Captured with the Phoenix ICON (100° field of view). Wide-field fundus photograph of an infant.
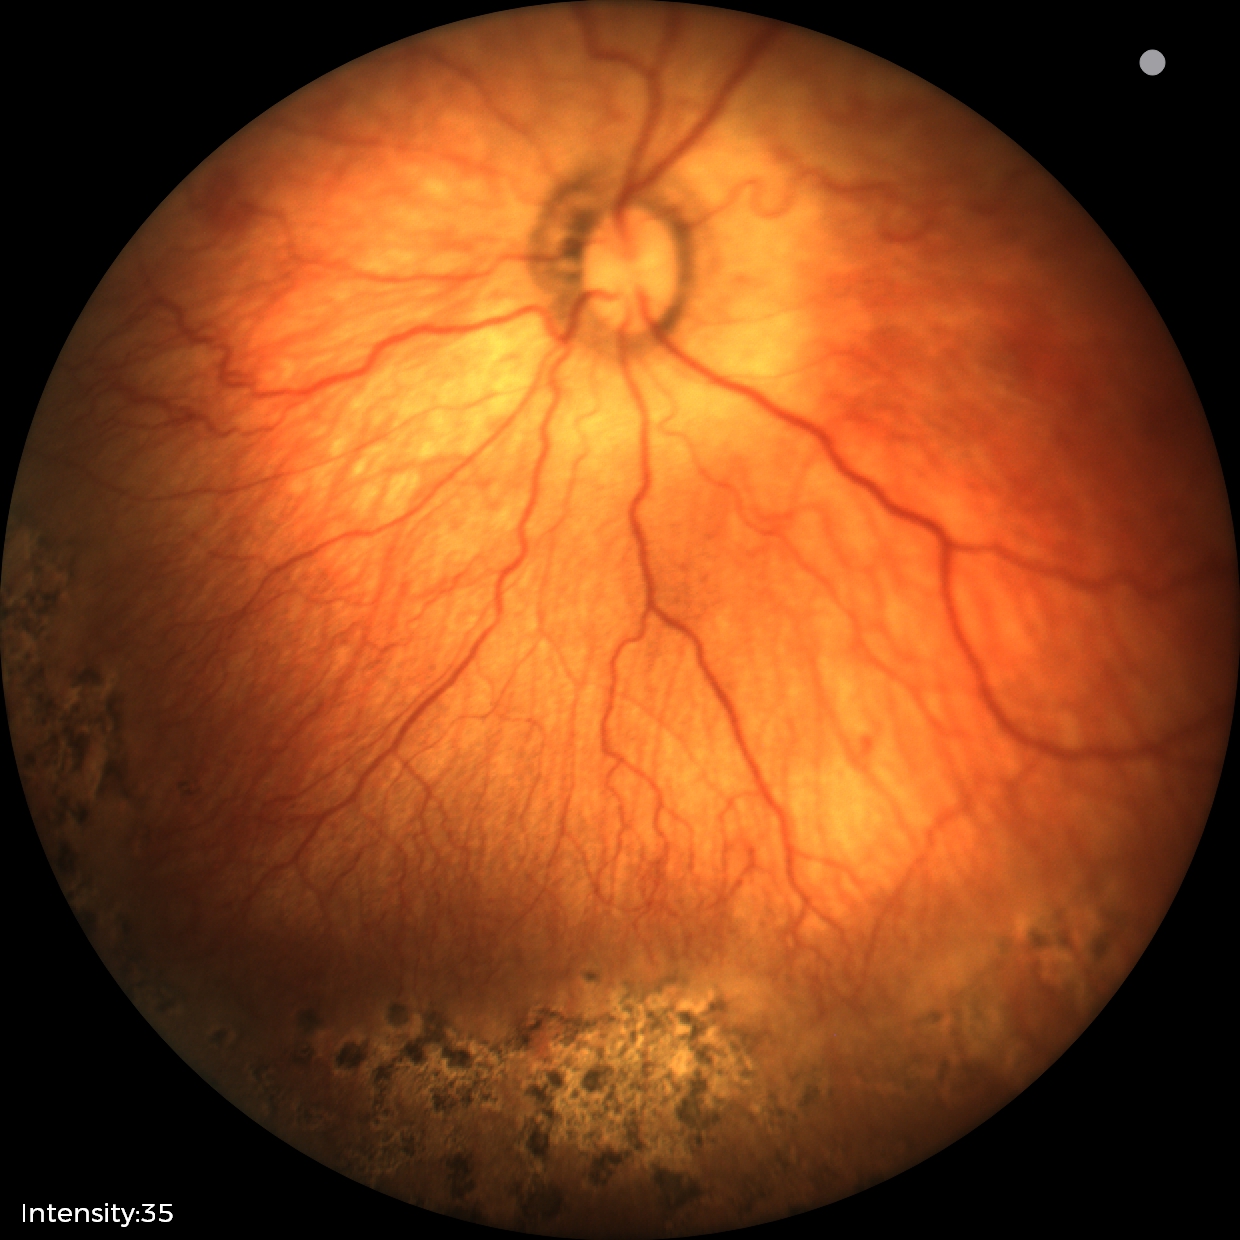 Examination diagnosed as retinopathy of prematurity (ROP) stage 1.